1515x1275 · fundus photo · 45-degree field of view: 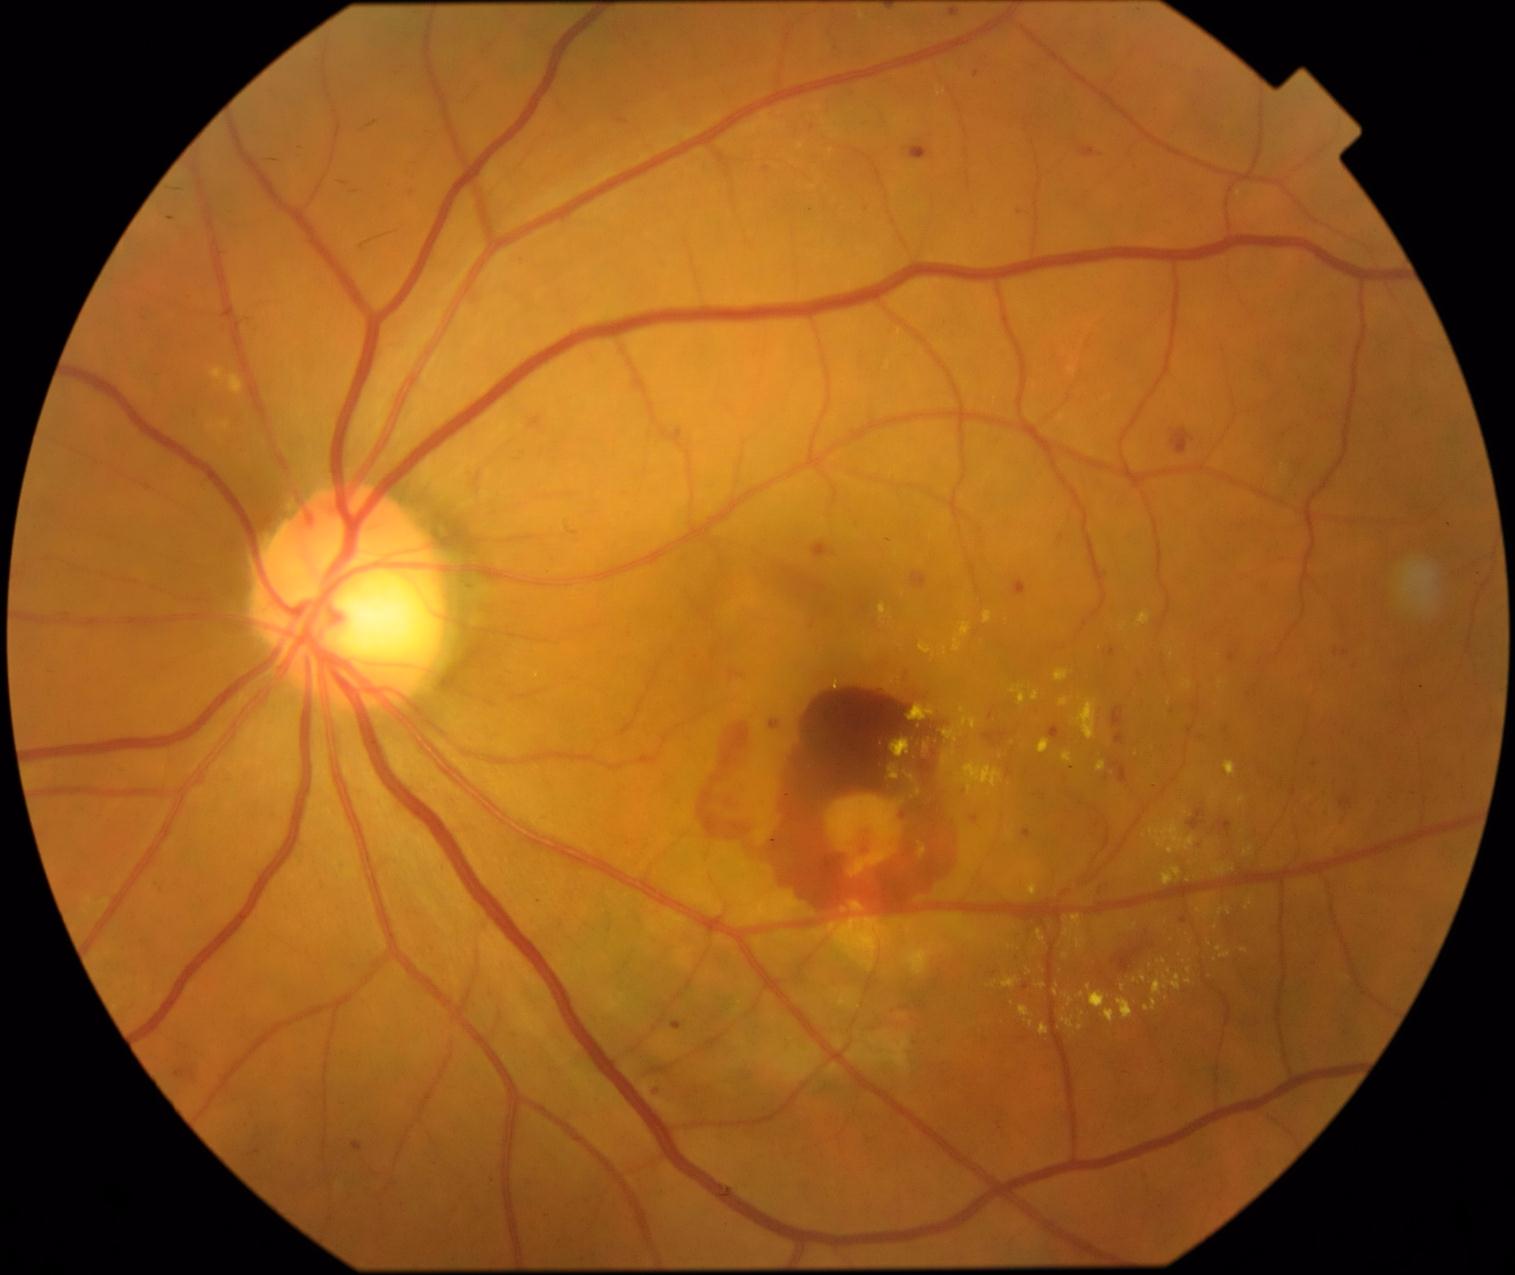

DR stage@grade 4 (PDR).